Wide-field contact fundus photograph of an infant
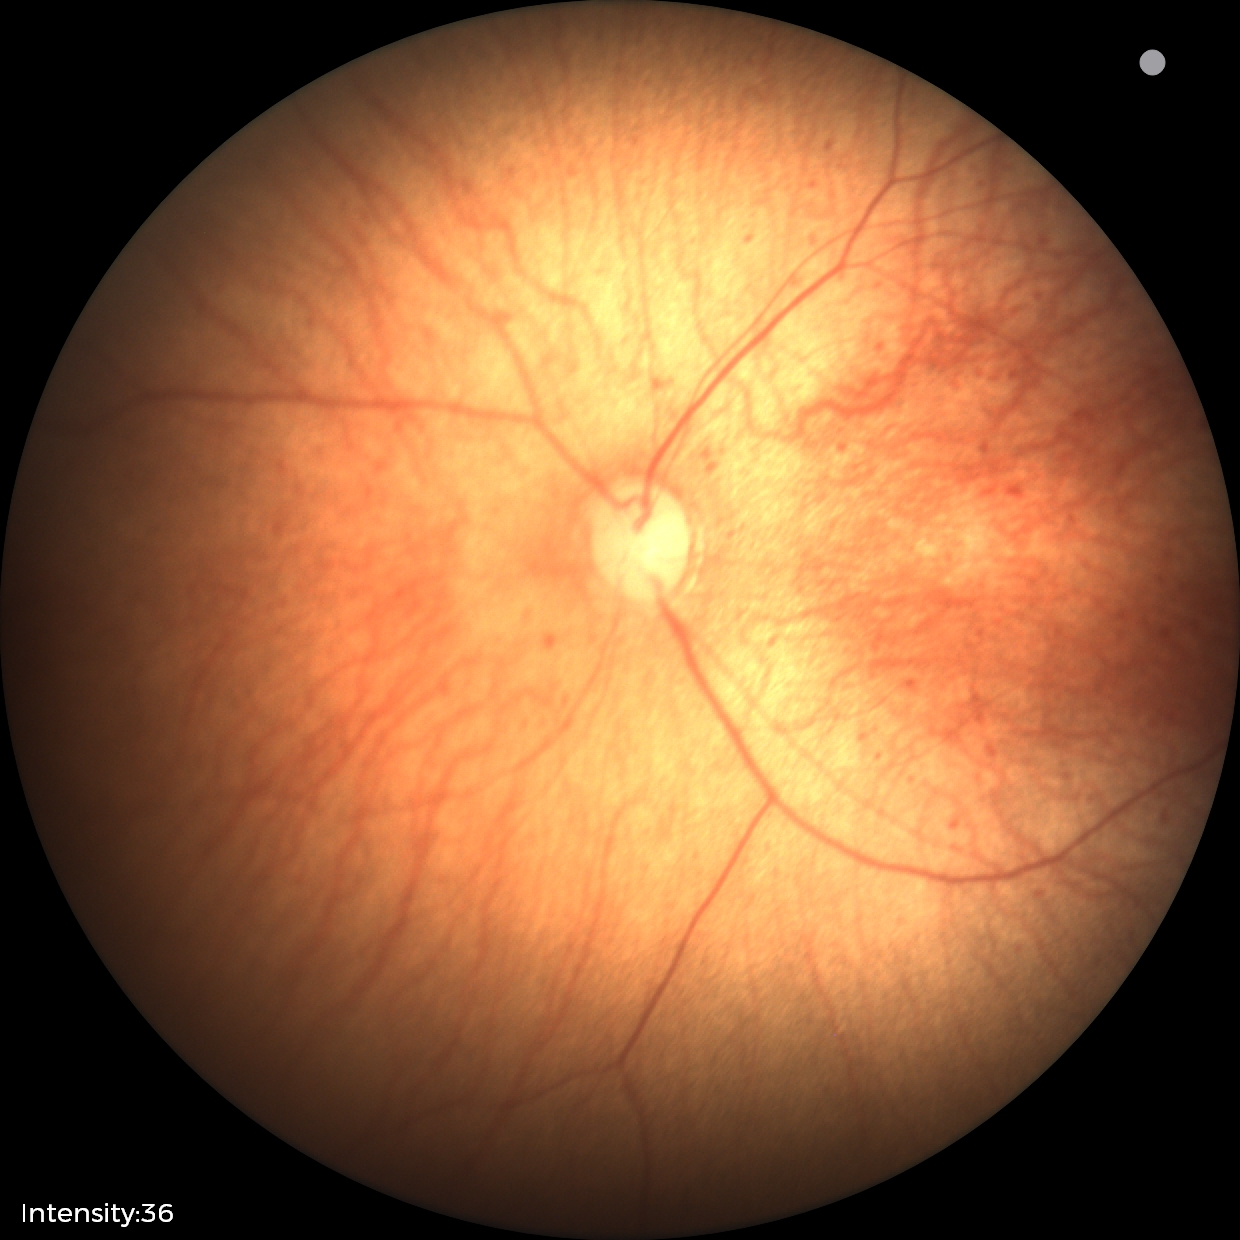 Screening examination with no abnormal retinal findings.